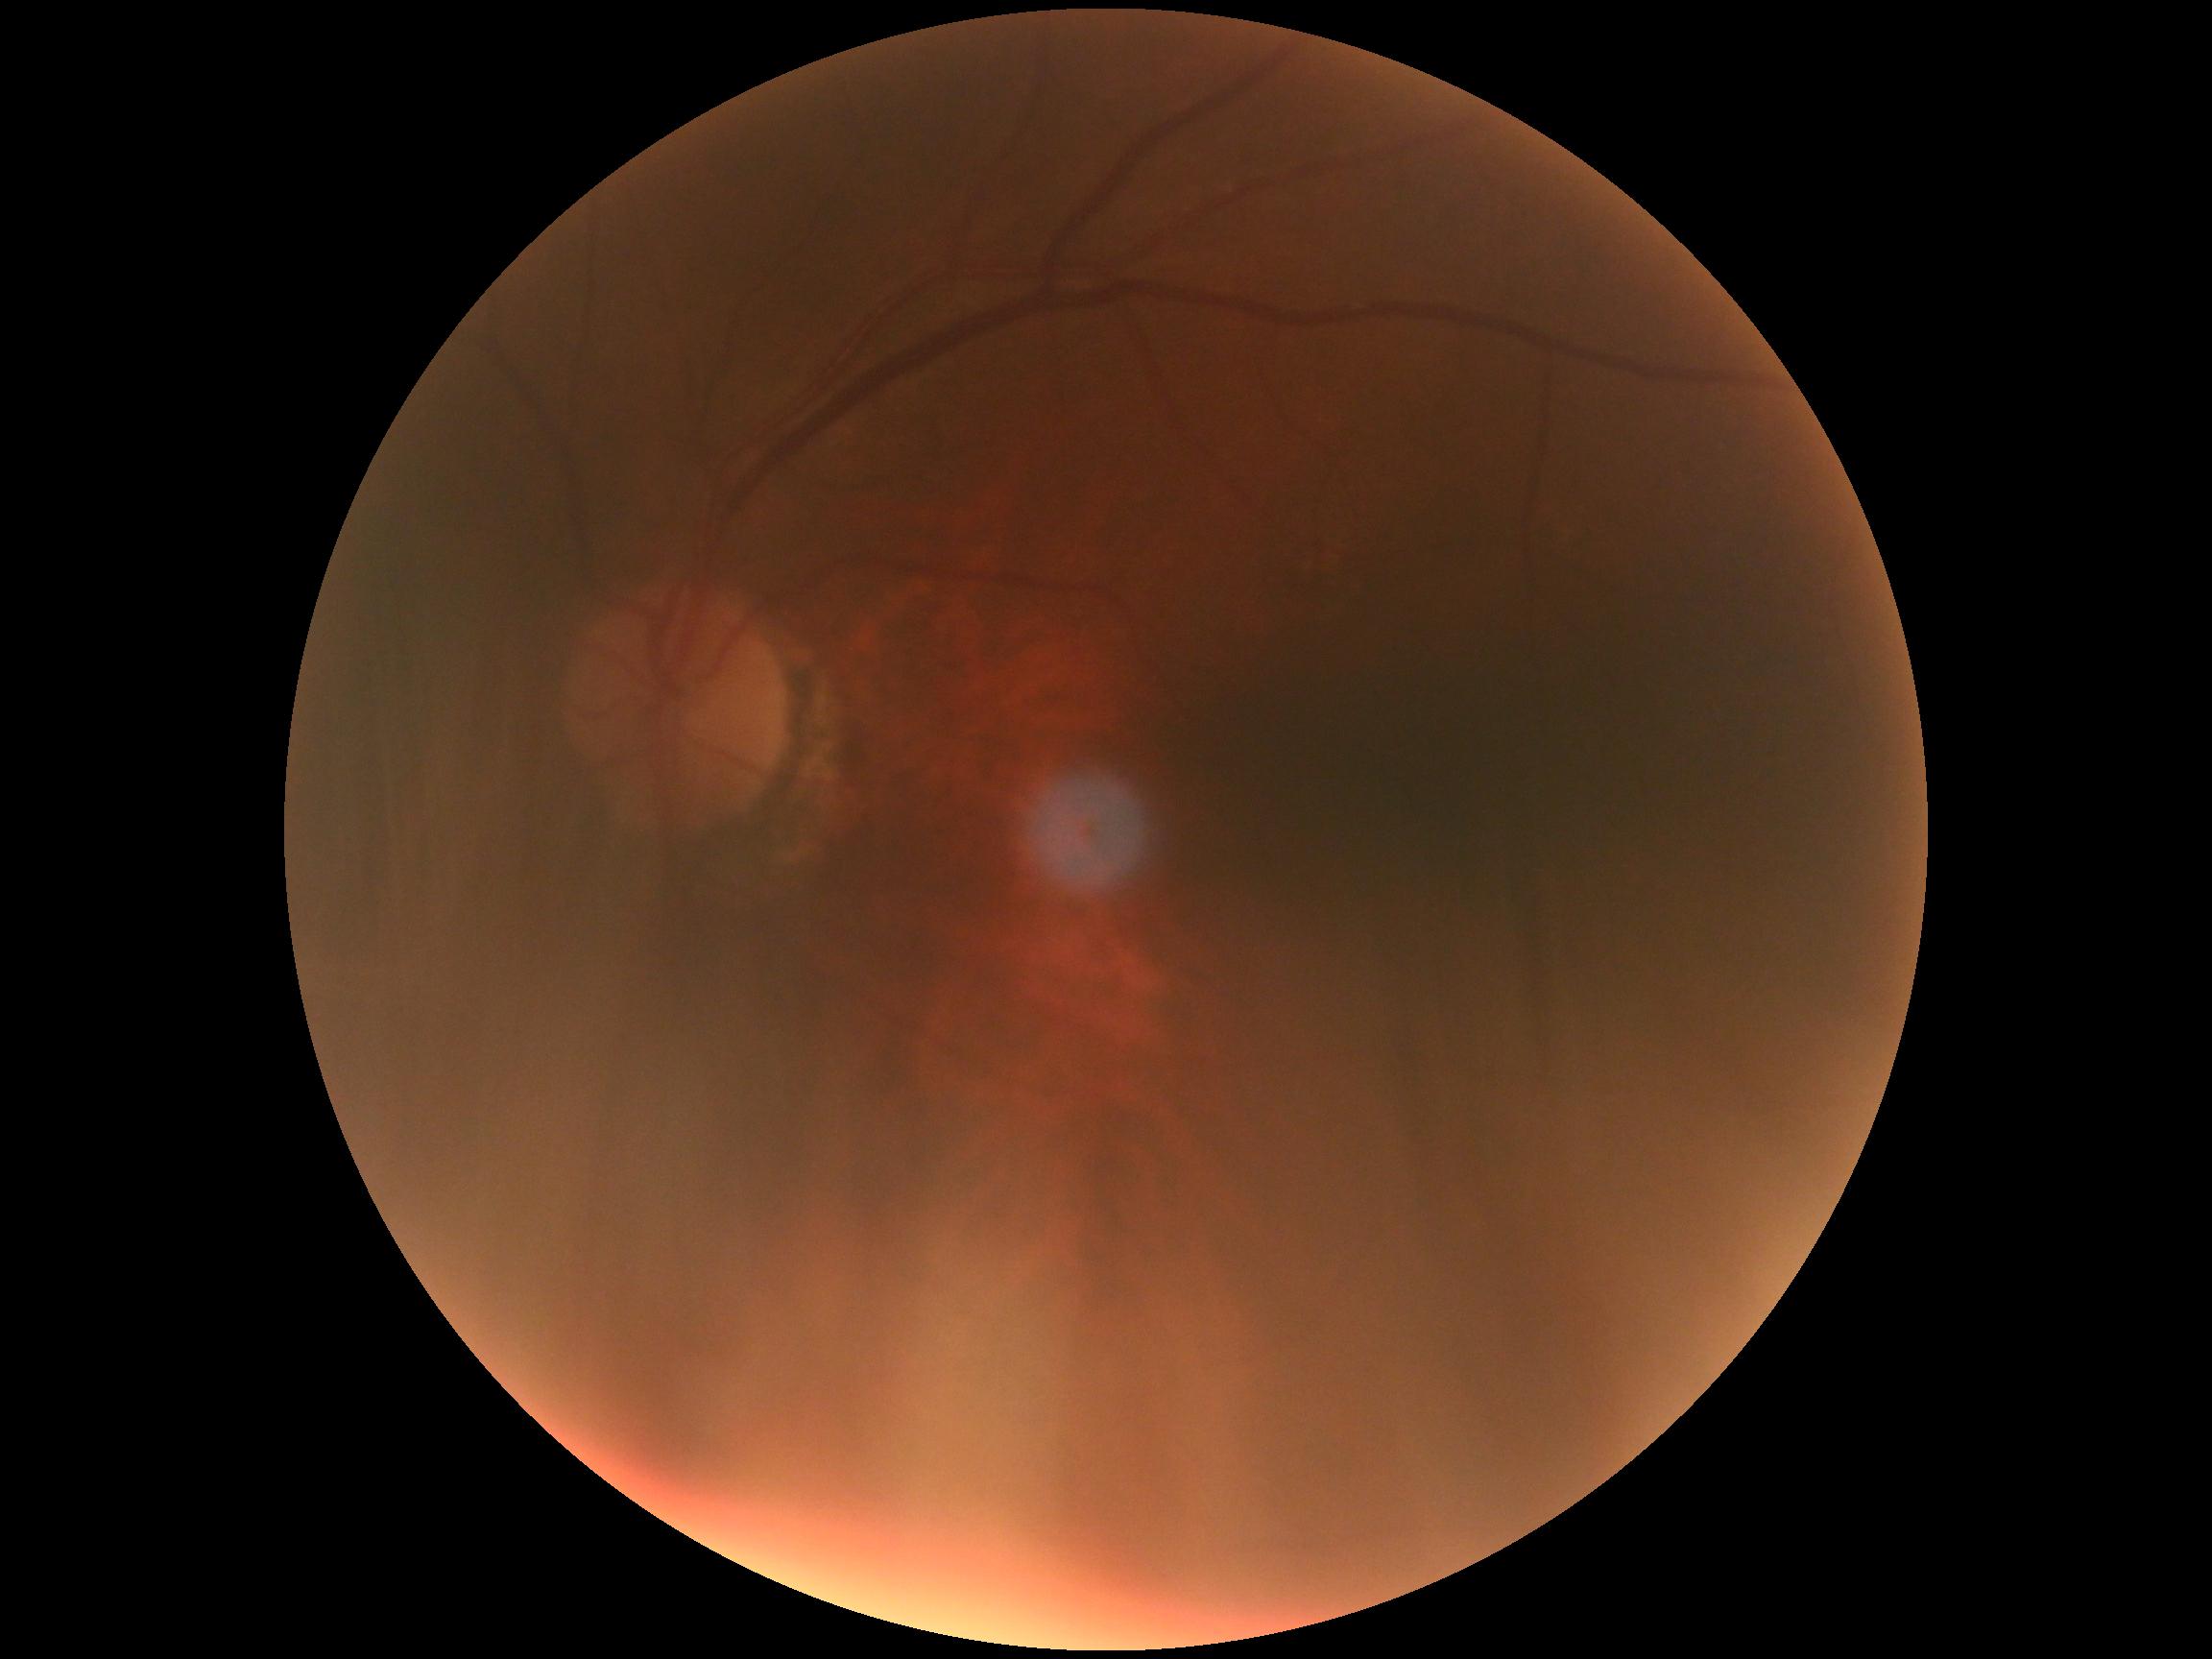 * diabetic retinopathy (DR) — grade 0 (no apparent retinopathy)